200-degree field of view. Ultra-widefield fundus photograph:
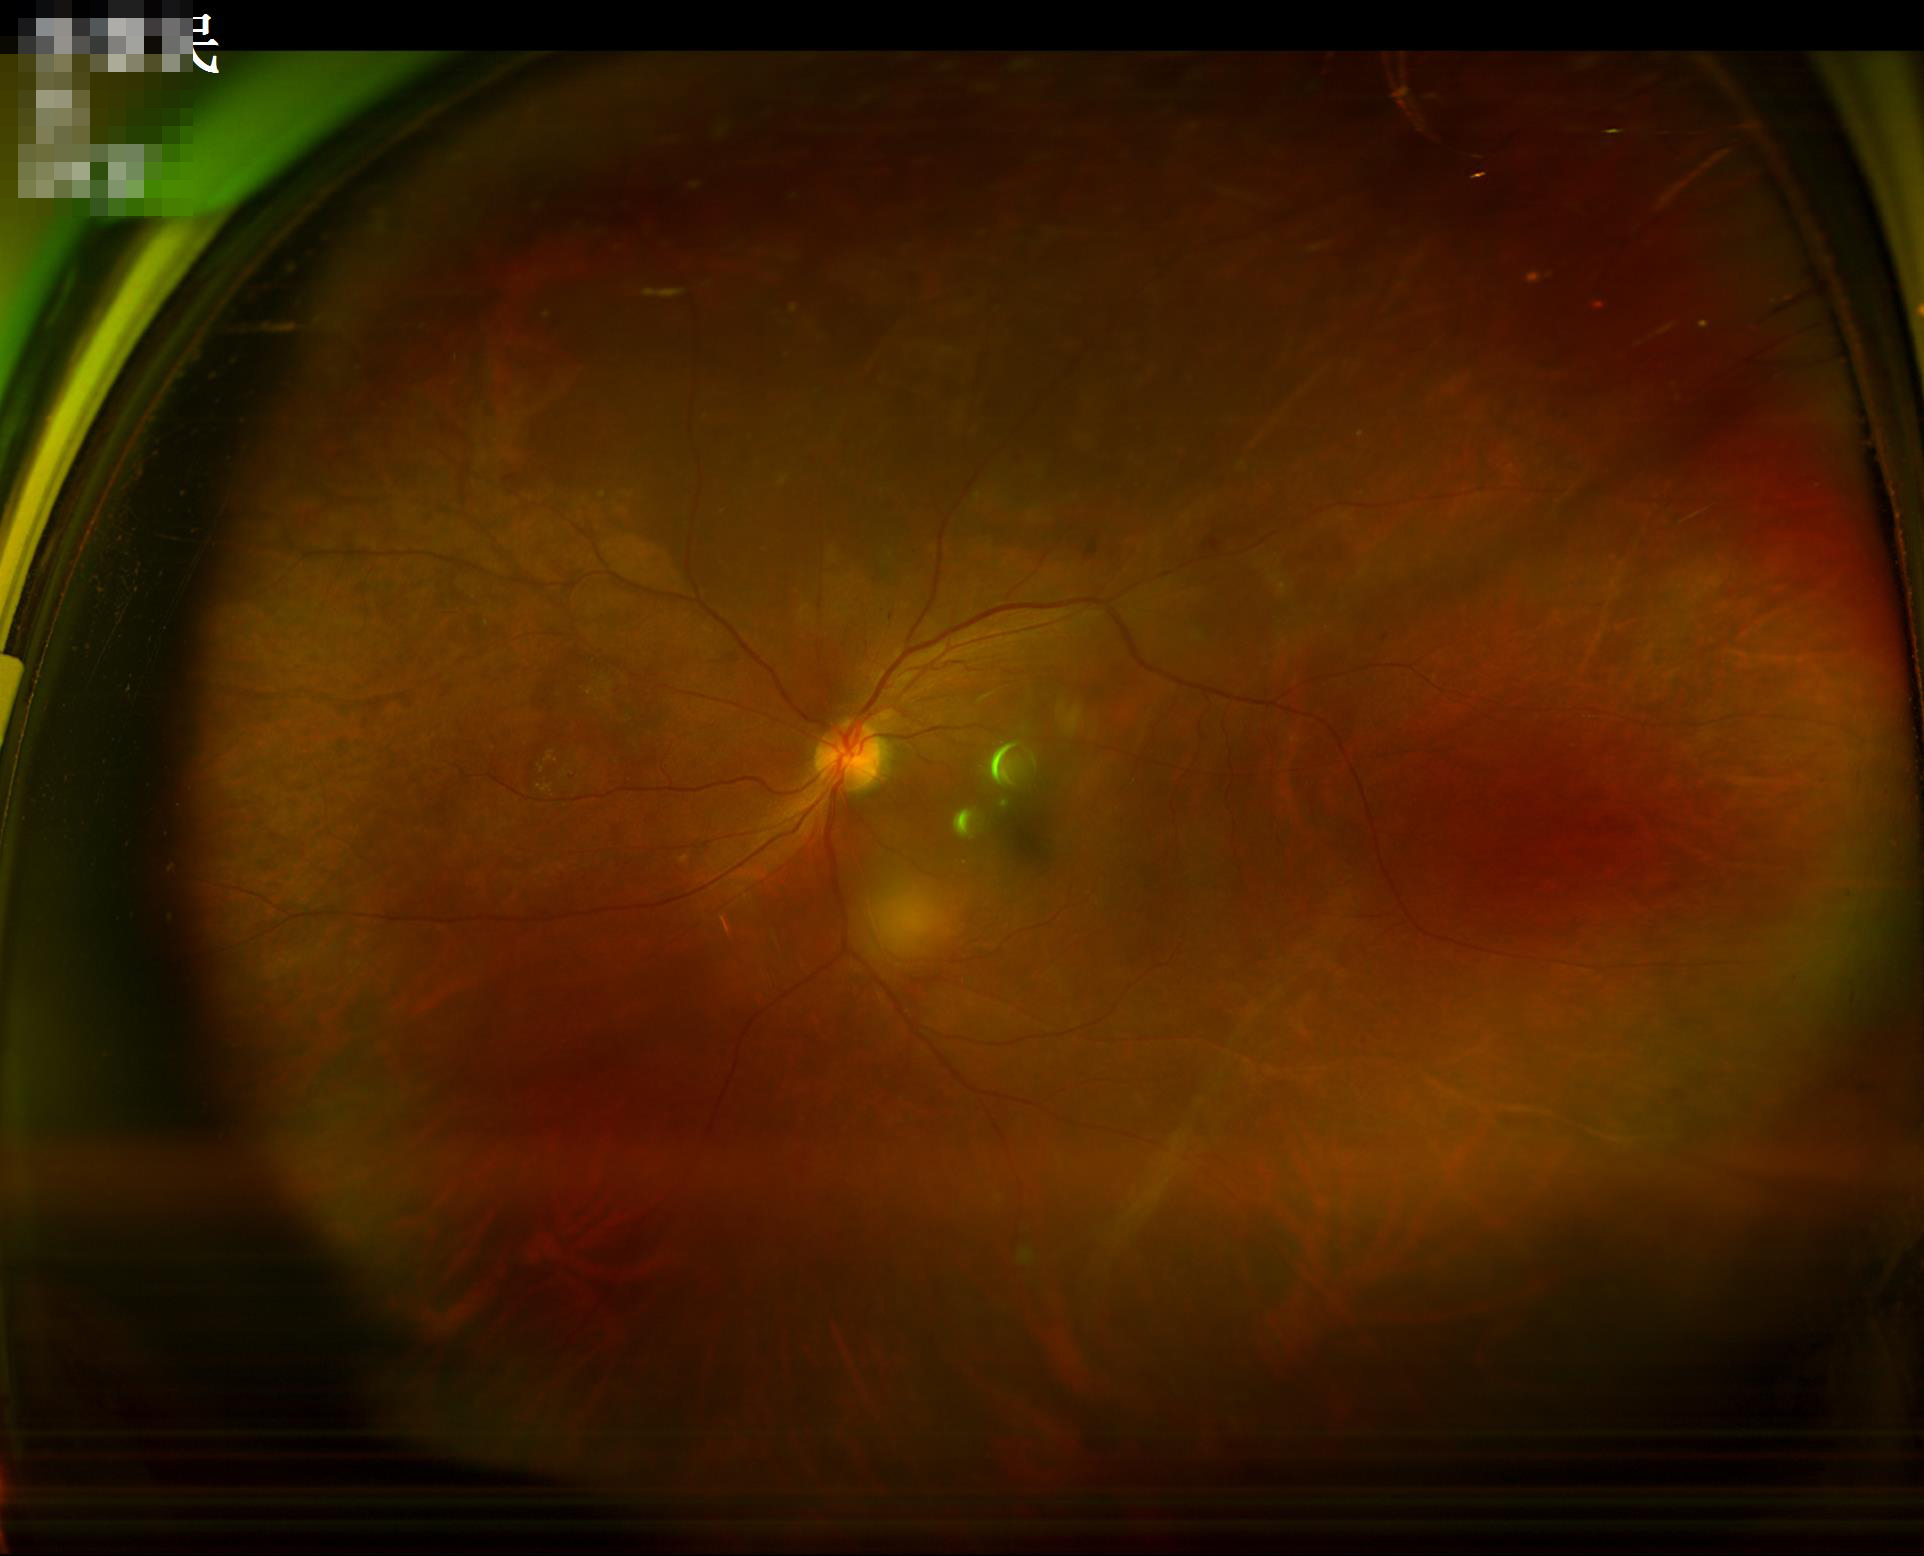
illumination: over- or under-exposed
contrast: vessels and details readily distinguishable
clarity: sharp throughout the field
overall_quality: adequate for clinical interpretation